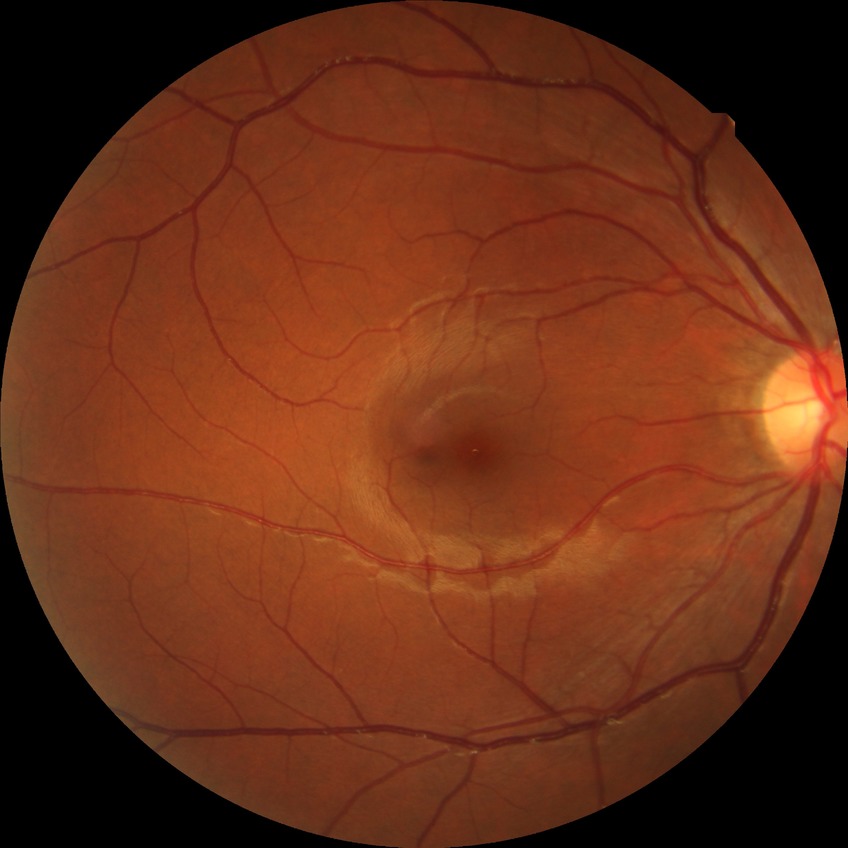

Modified Davis classification: no diabetic retinopathy.